FOV: 45 degrees:
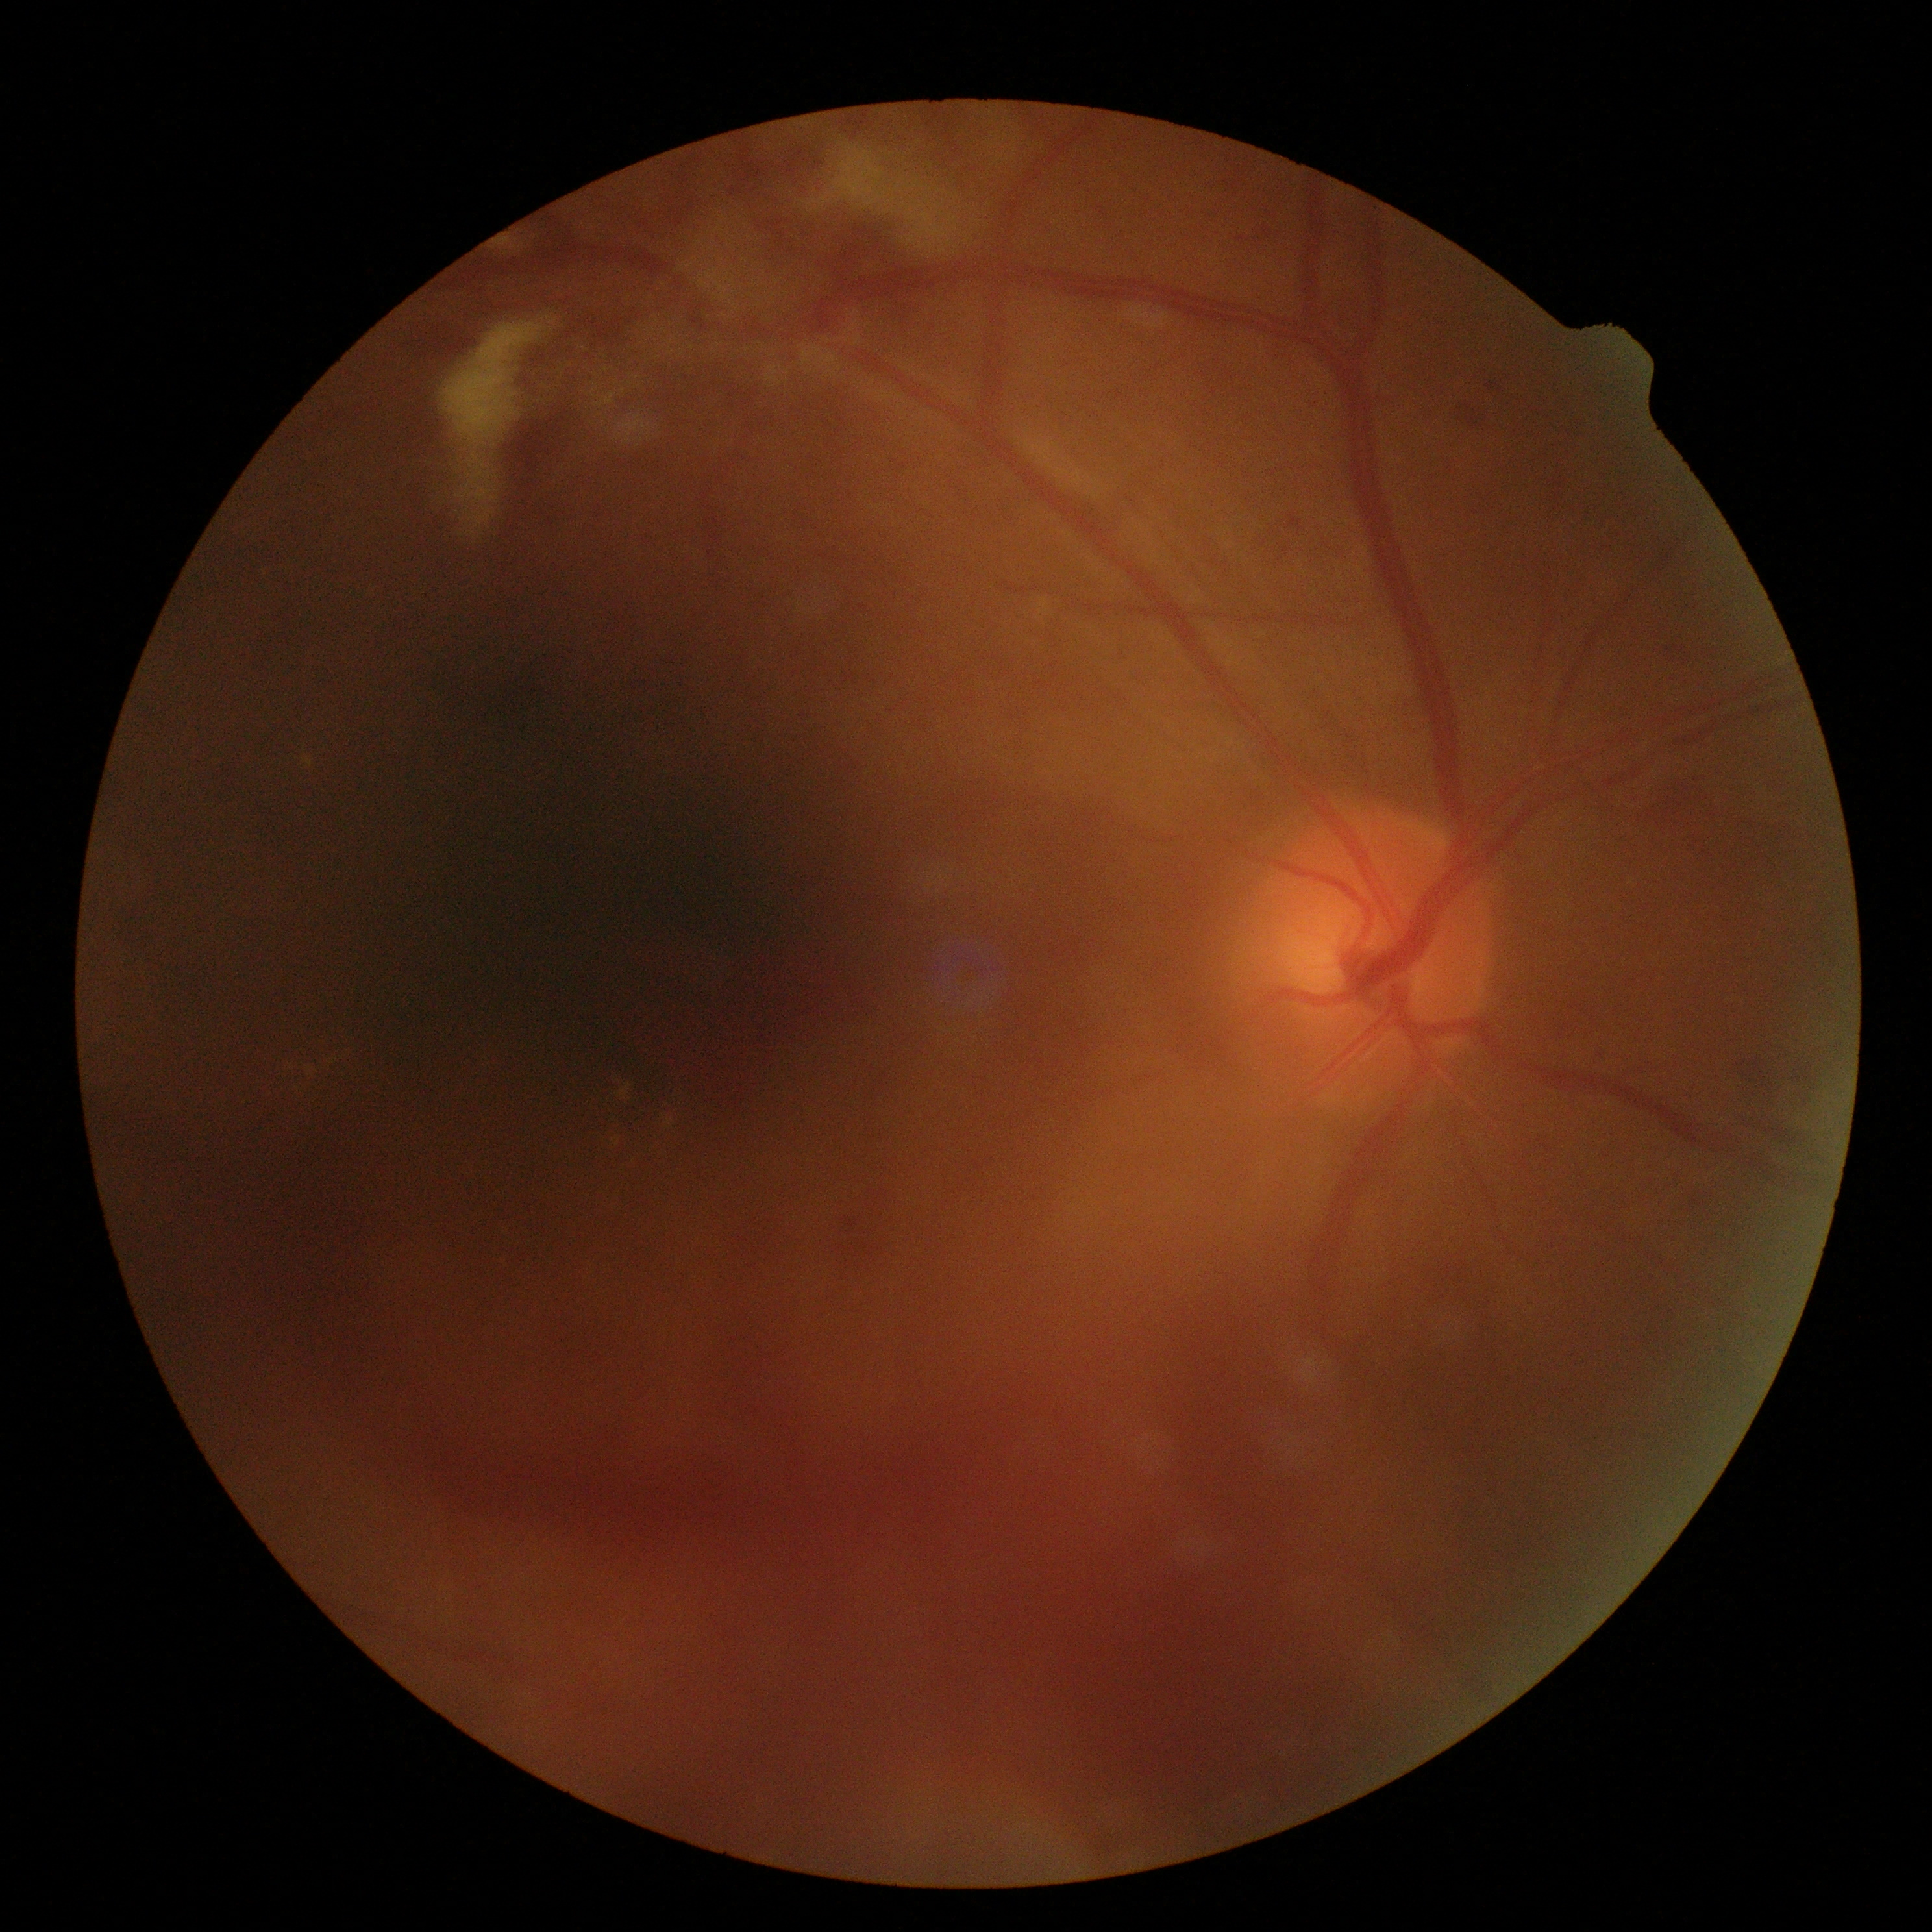

Retinopathy grade: 4/4.